240 x 240 pixels — 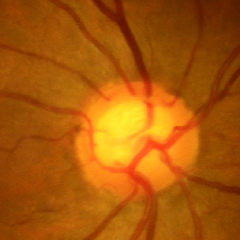
The image shows no glaucomatous findings.